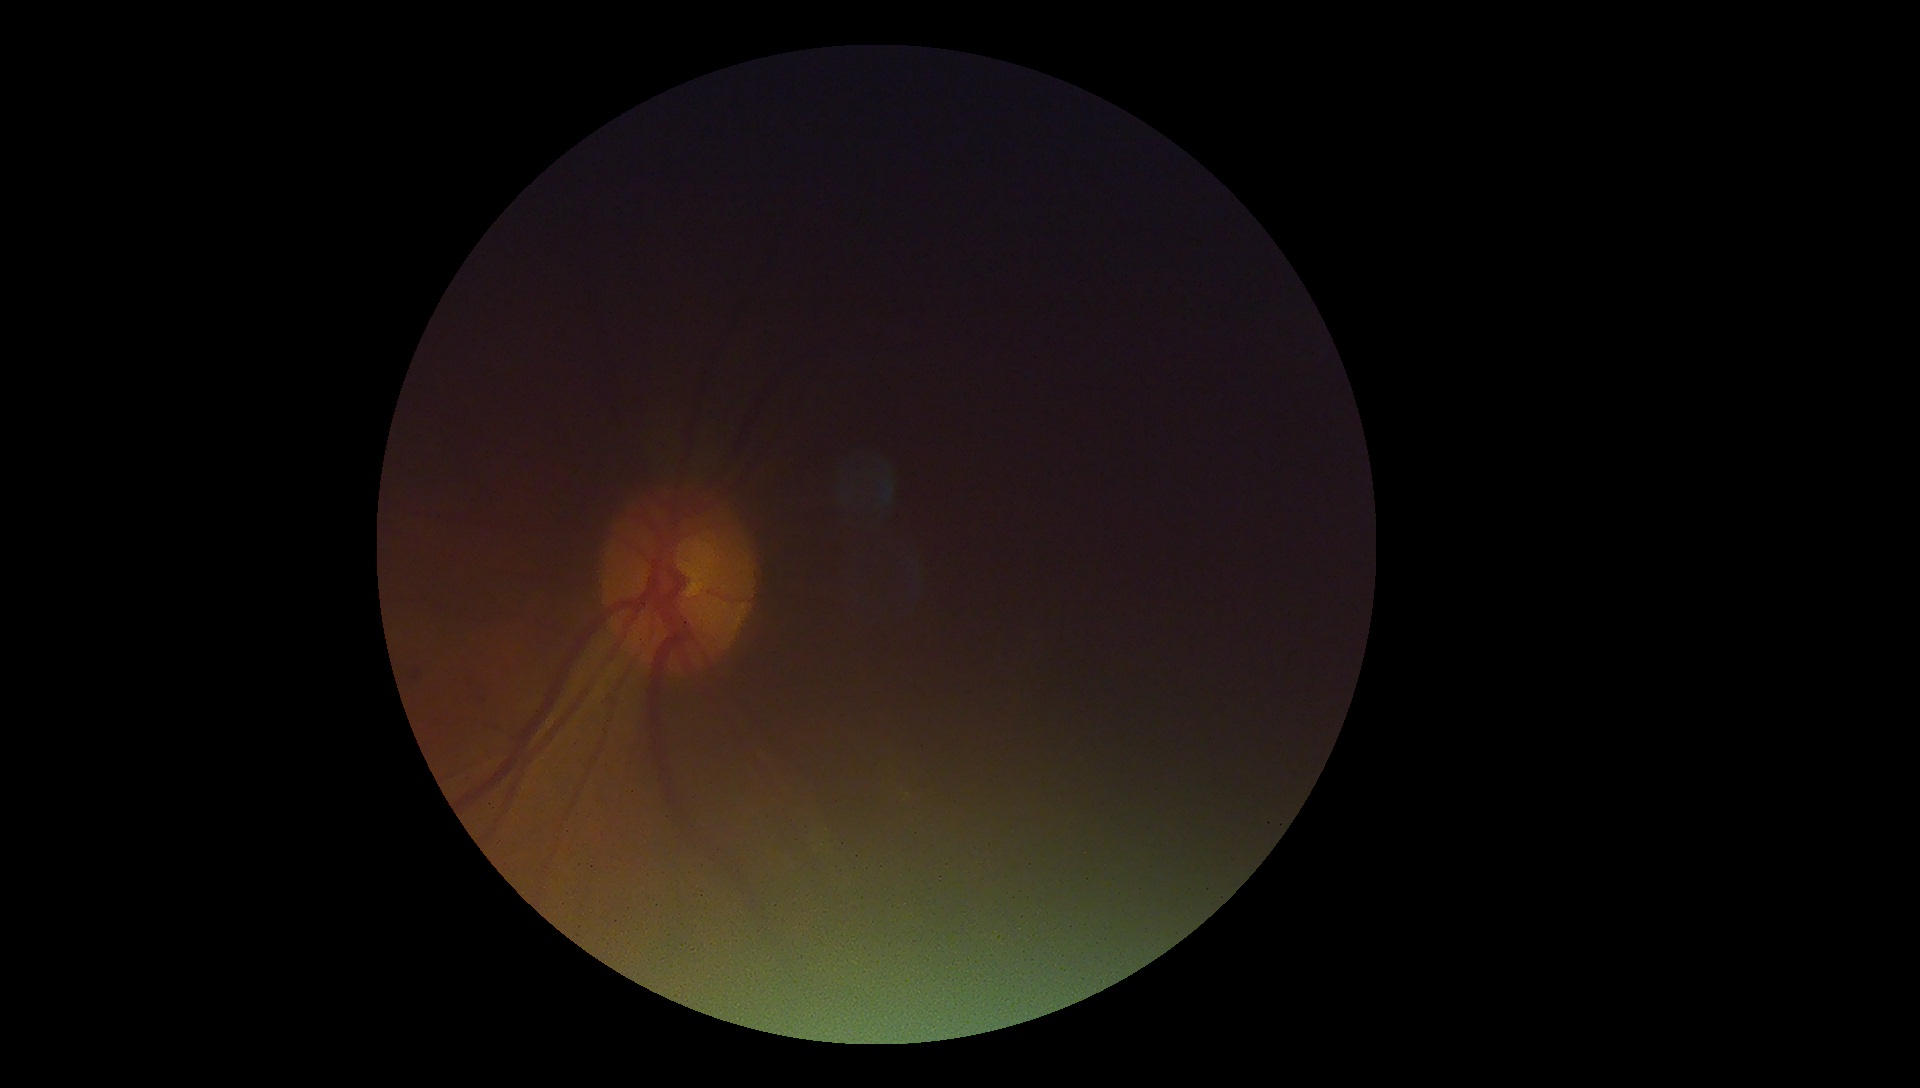 Retinopathy is ungradable due to poor image quality.